45° FOV; 2352 by 1568 pixels — 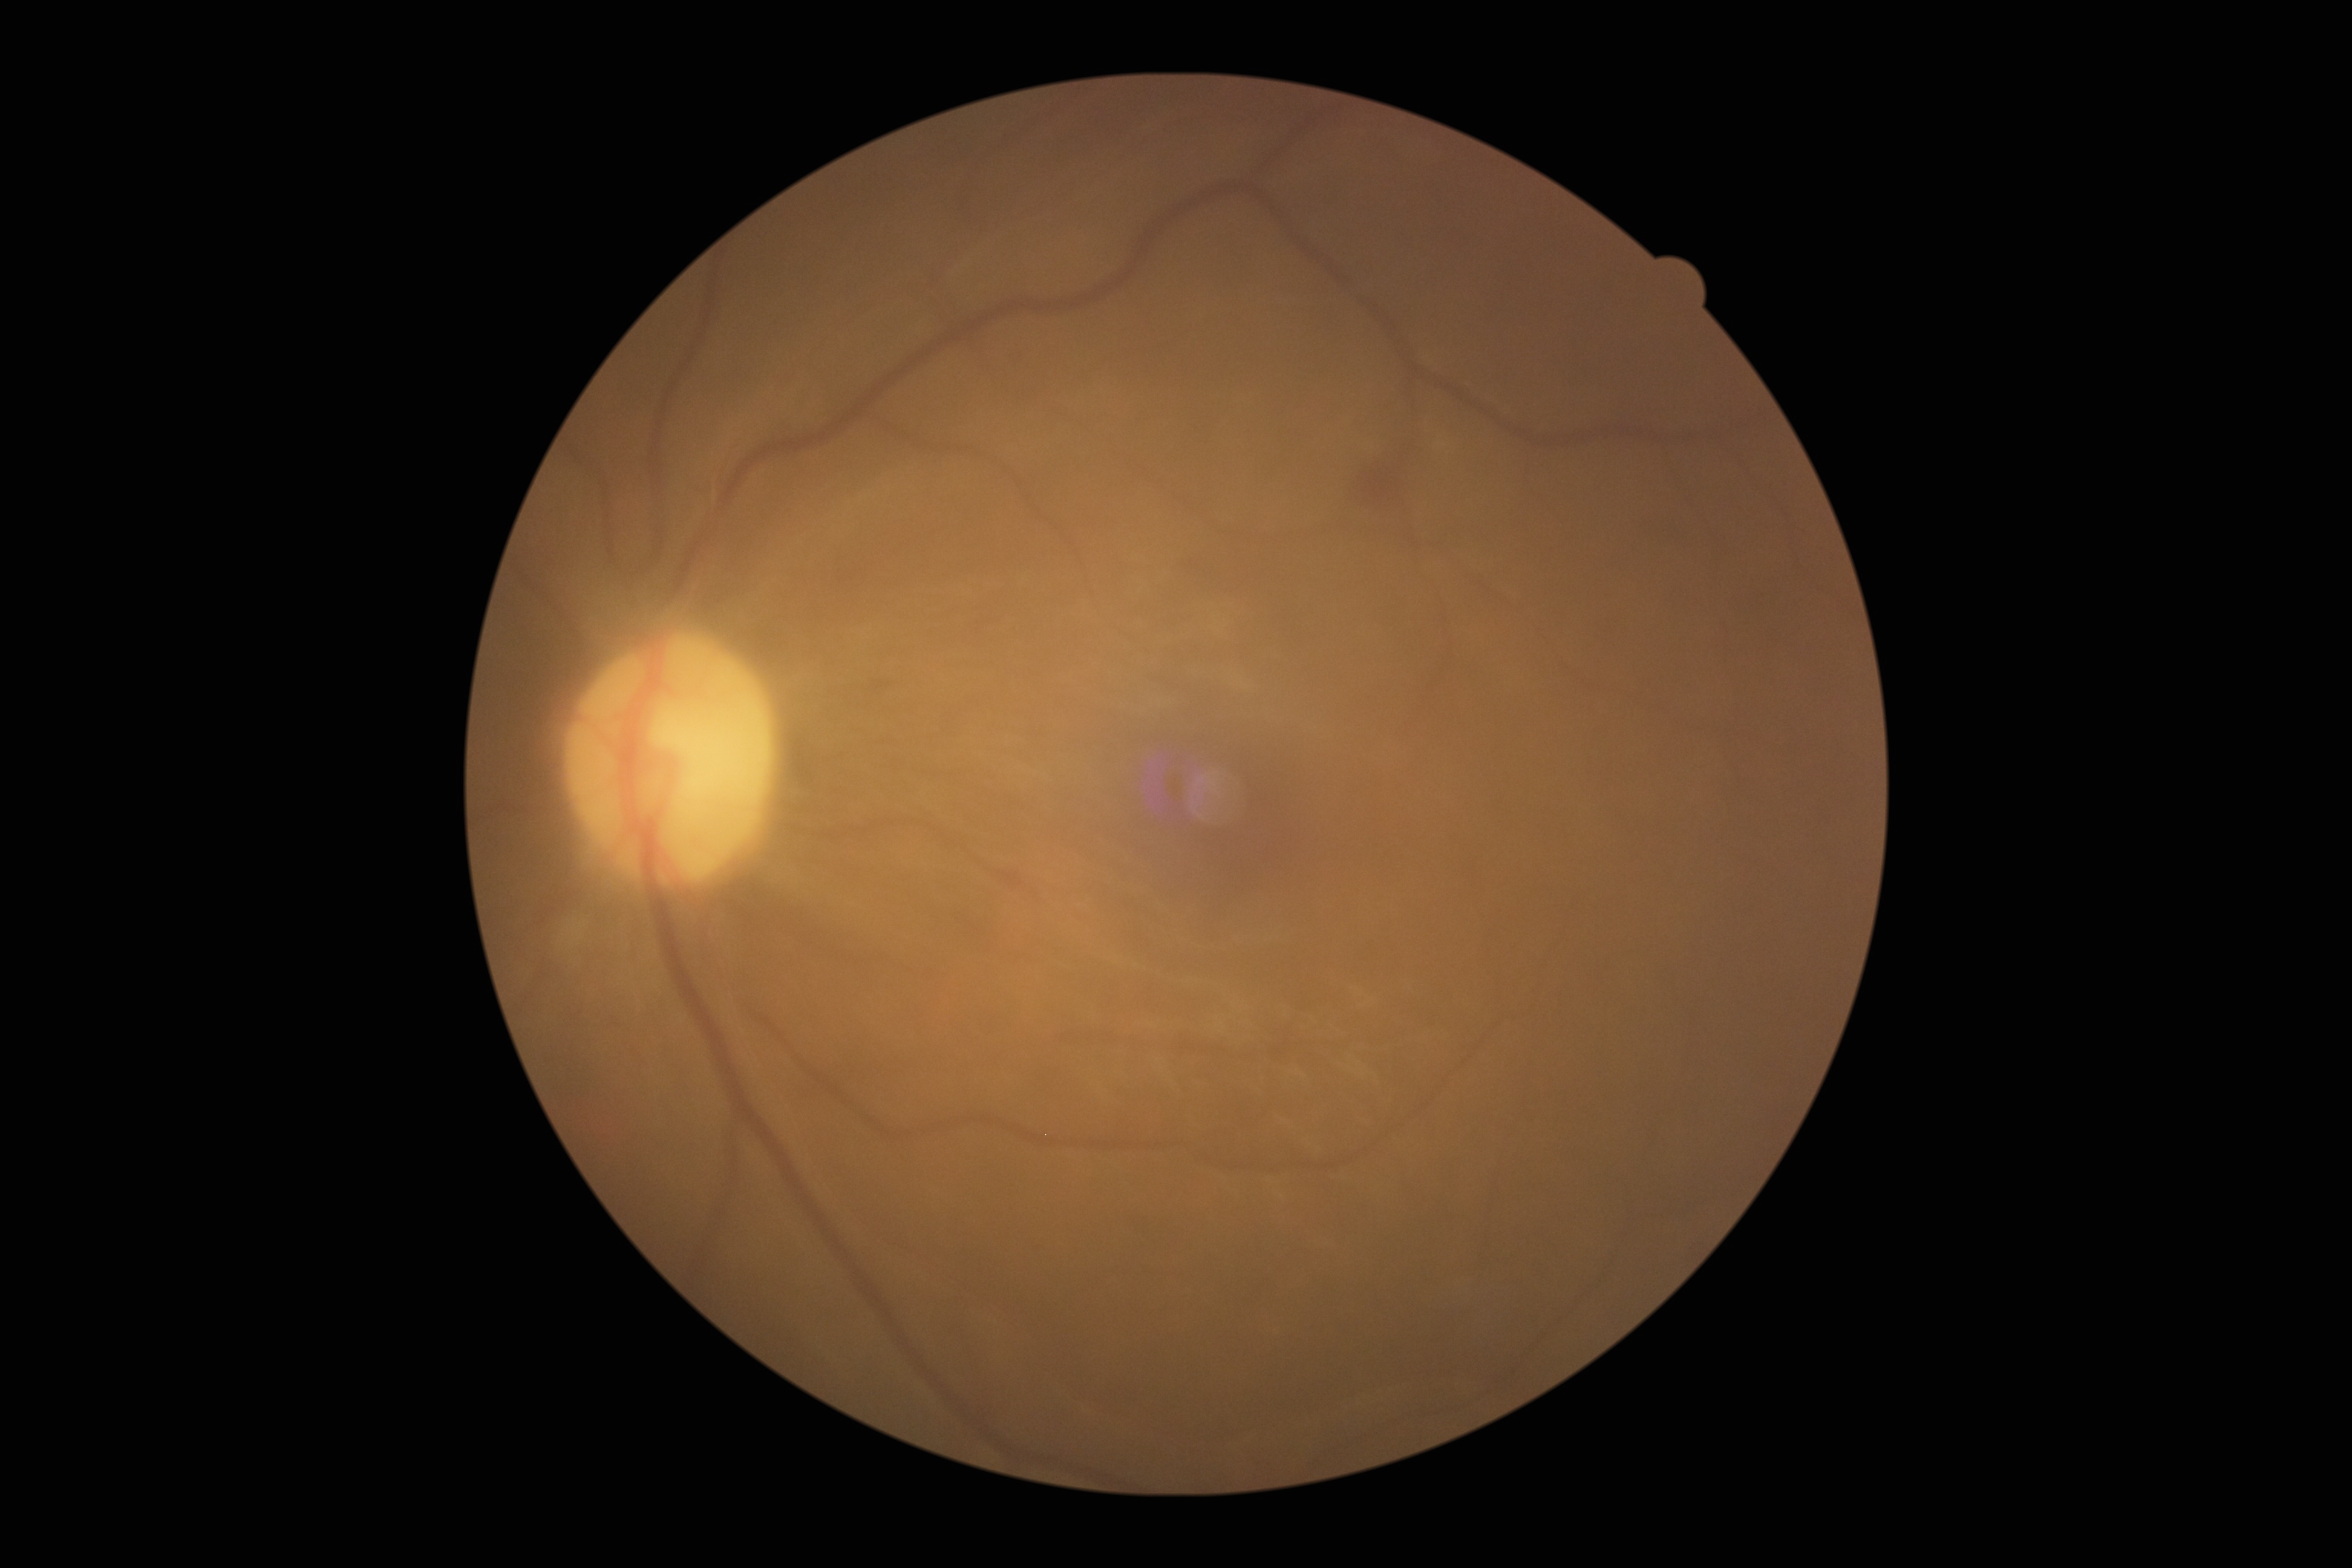 Disease class: non-proliferative diabetic retinopathy. DR severity: moderate NPDR (grade 2).